1960x1897px — 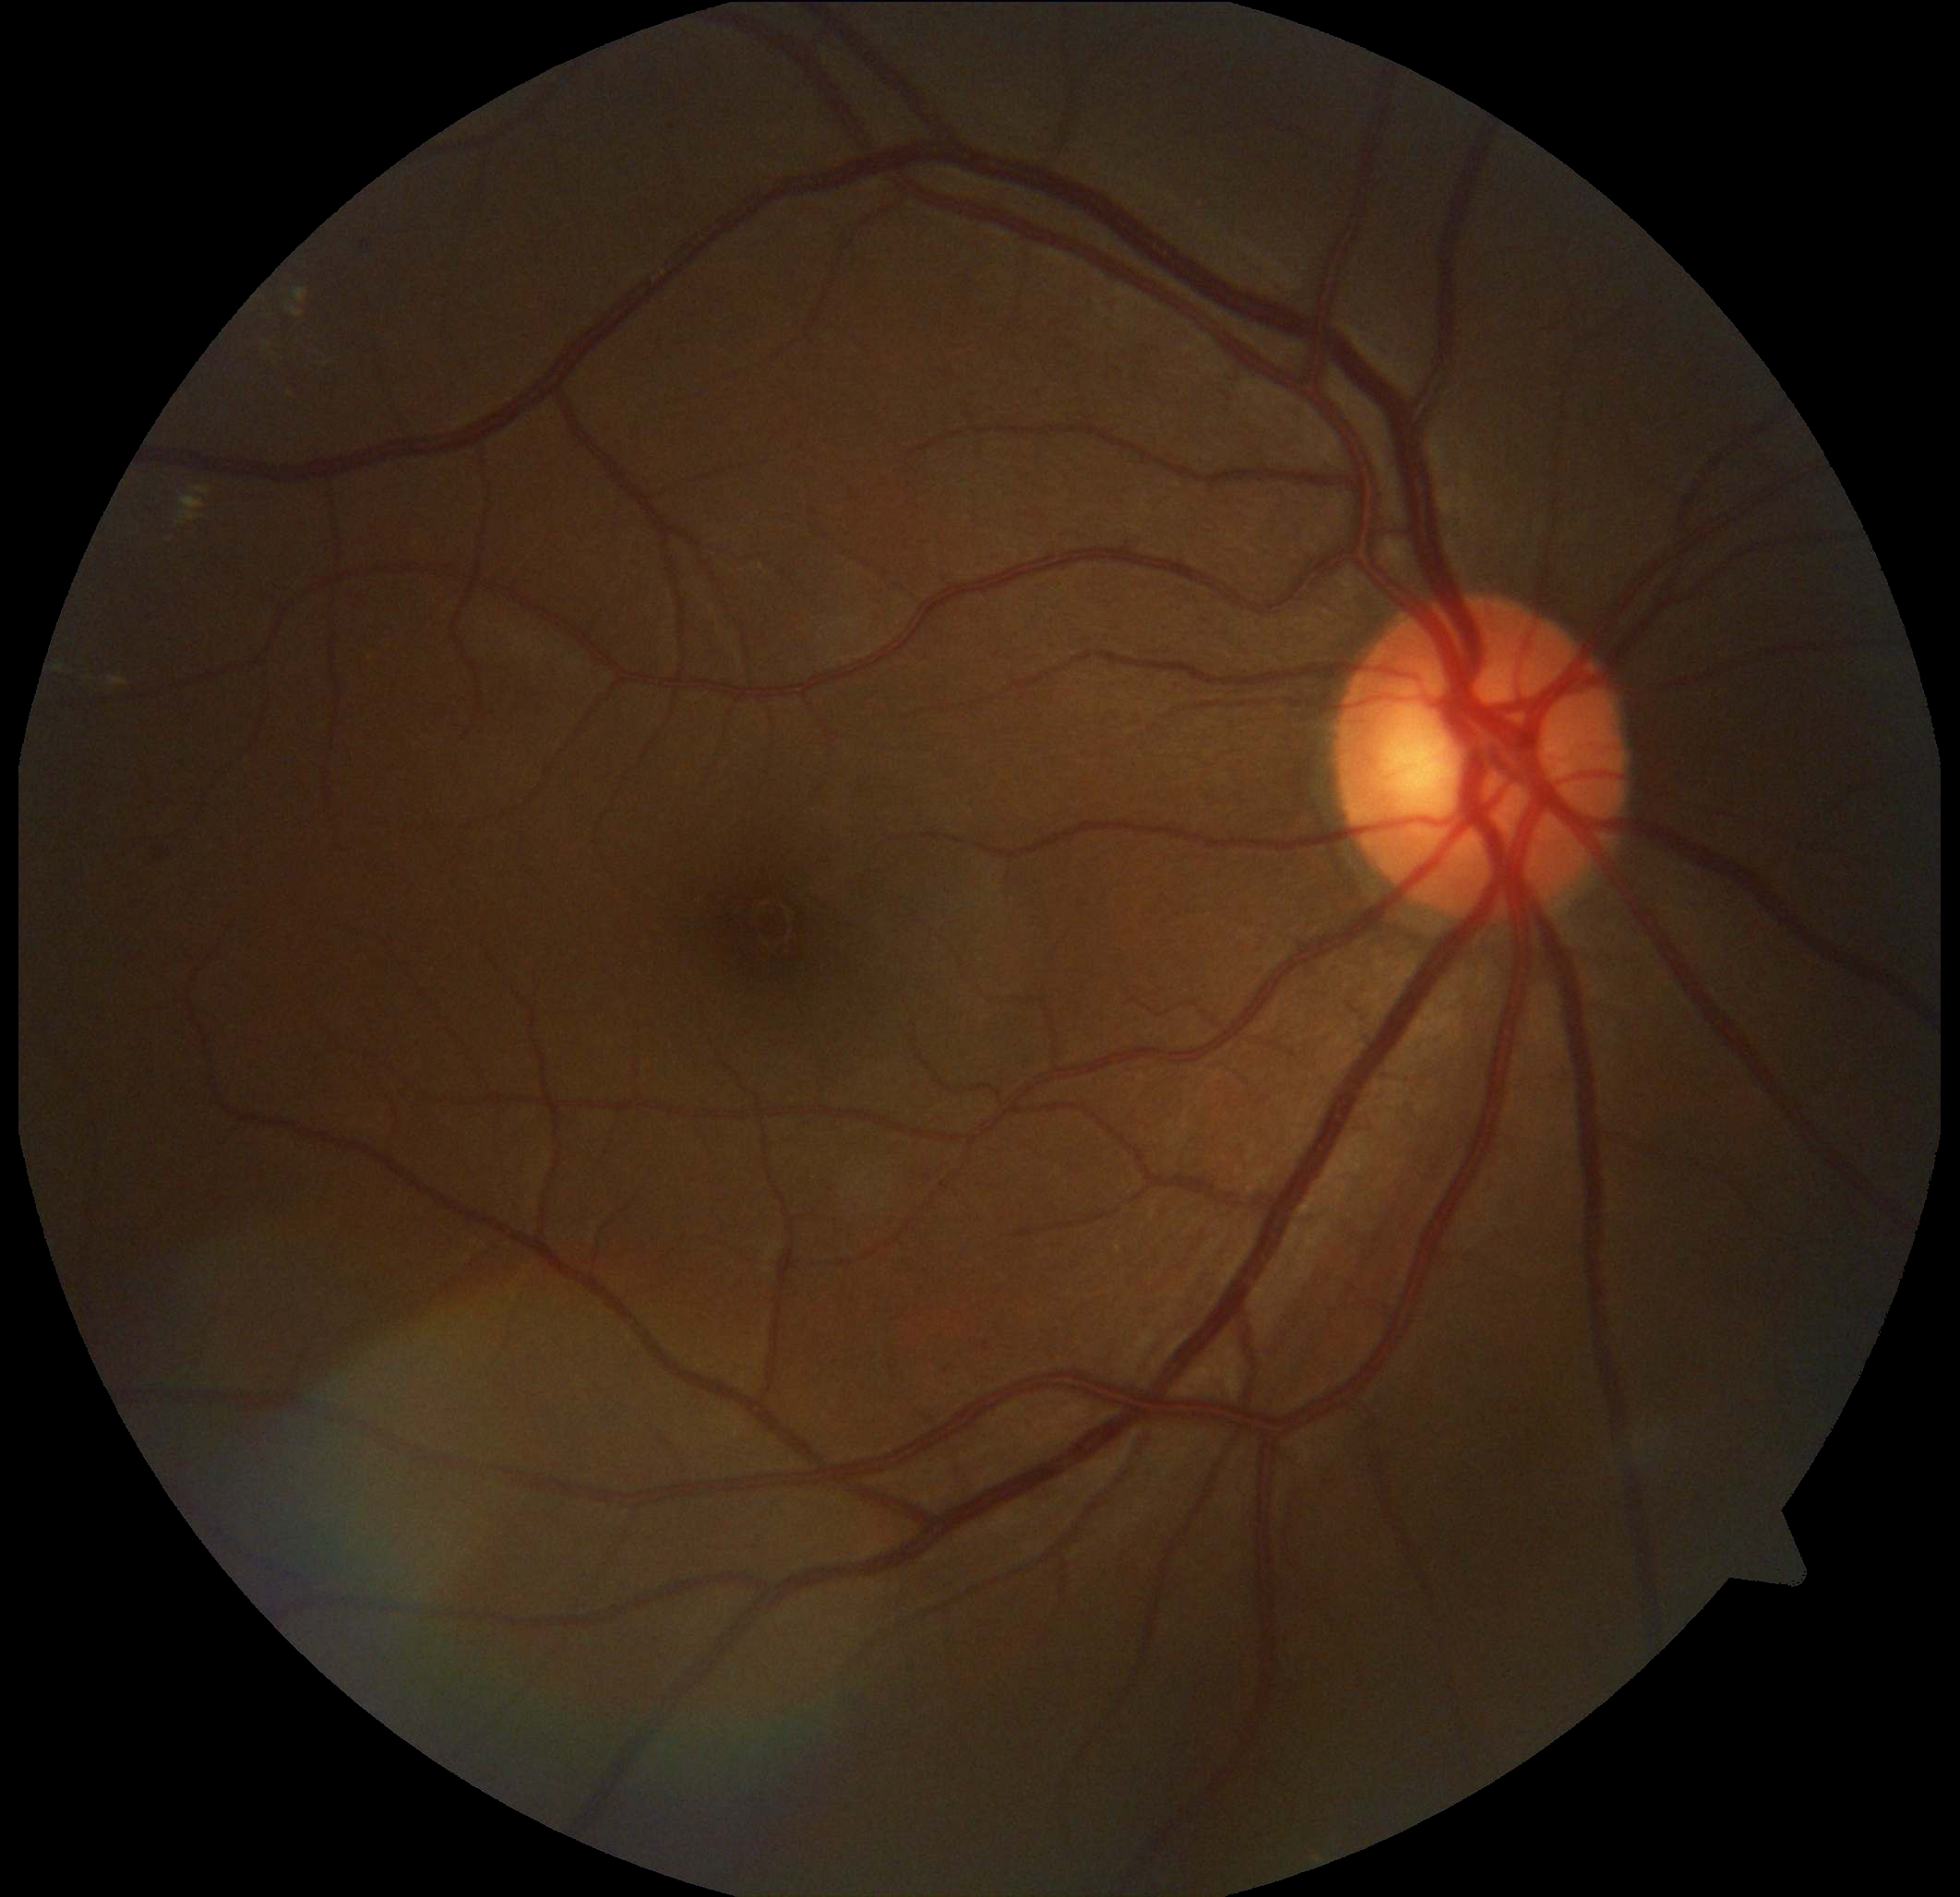 diabetic retinopathy grade: 2 (moderate NPDR), DR class: non-proliferative diabetic retinopathy.